Image size 2212x1659, 45-degree field of view
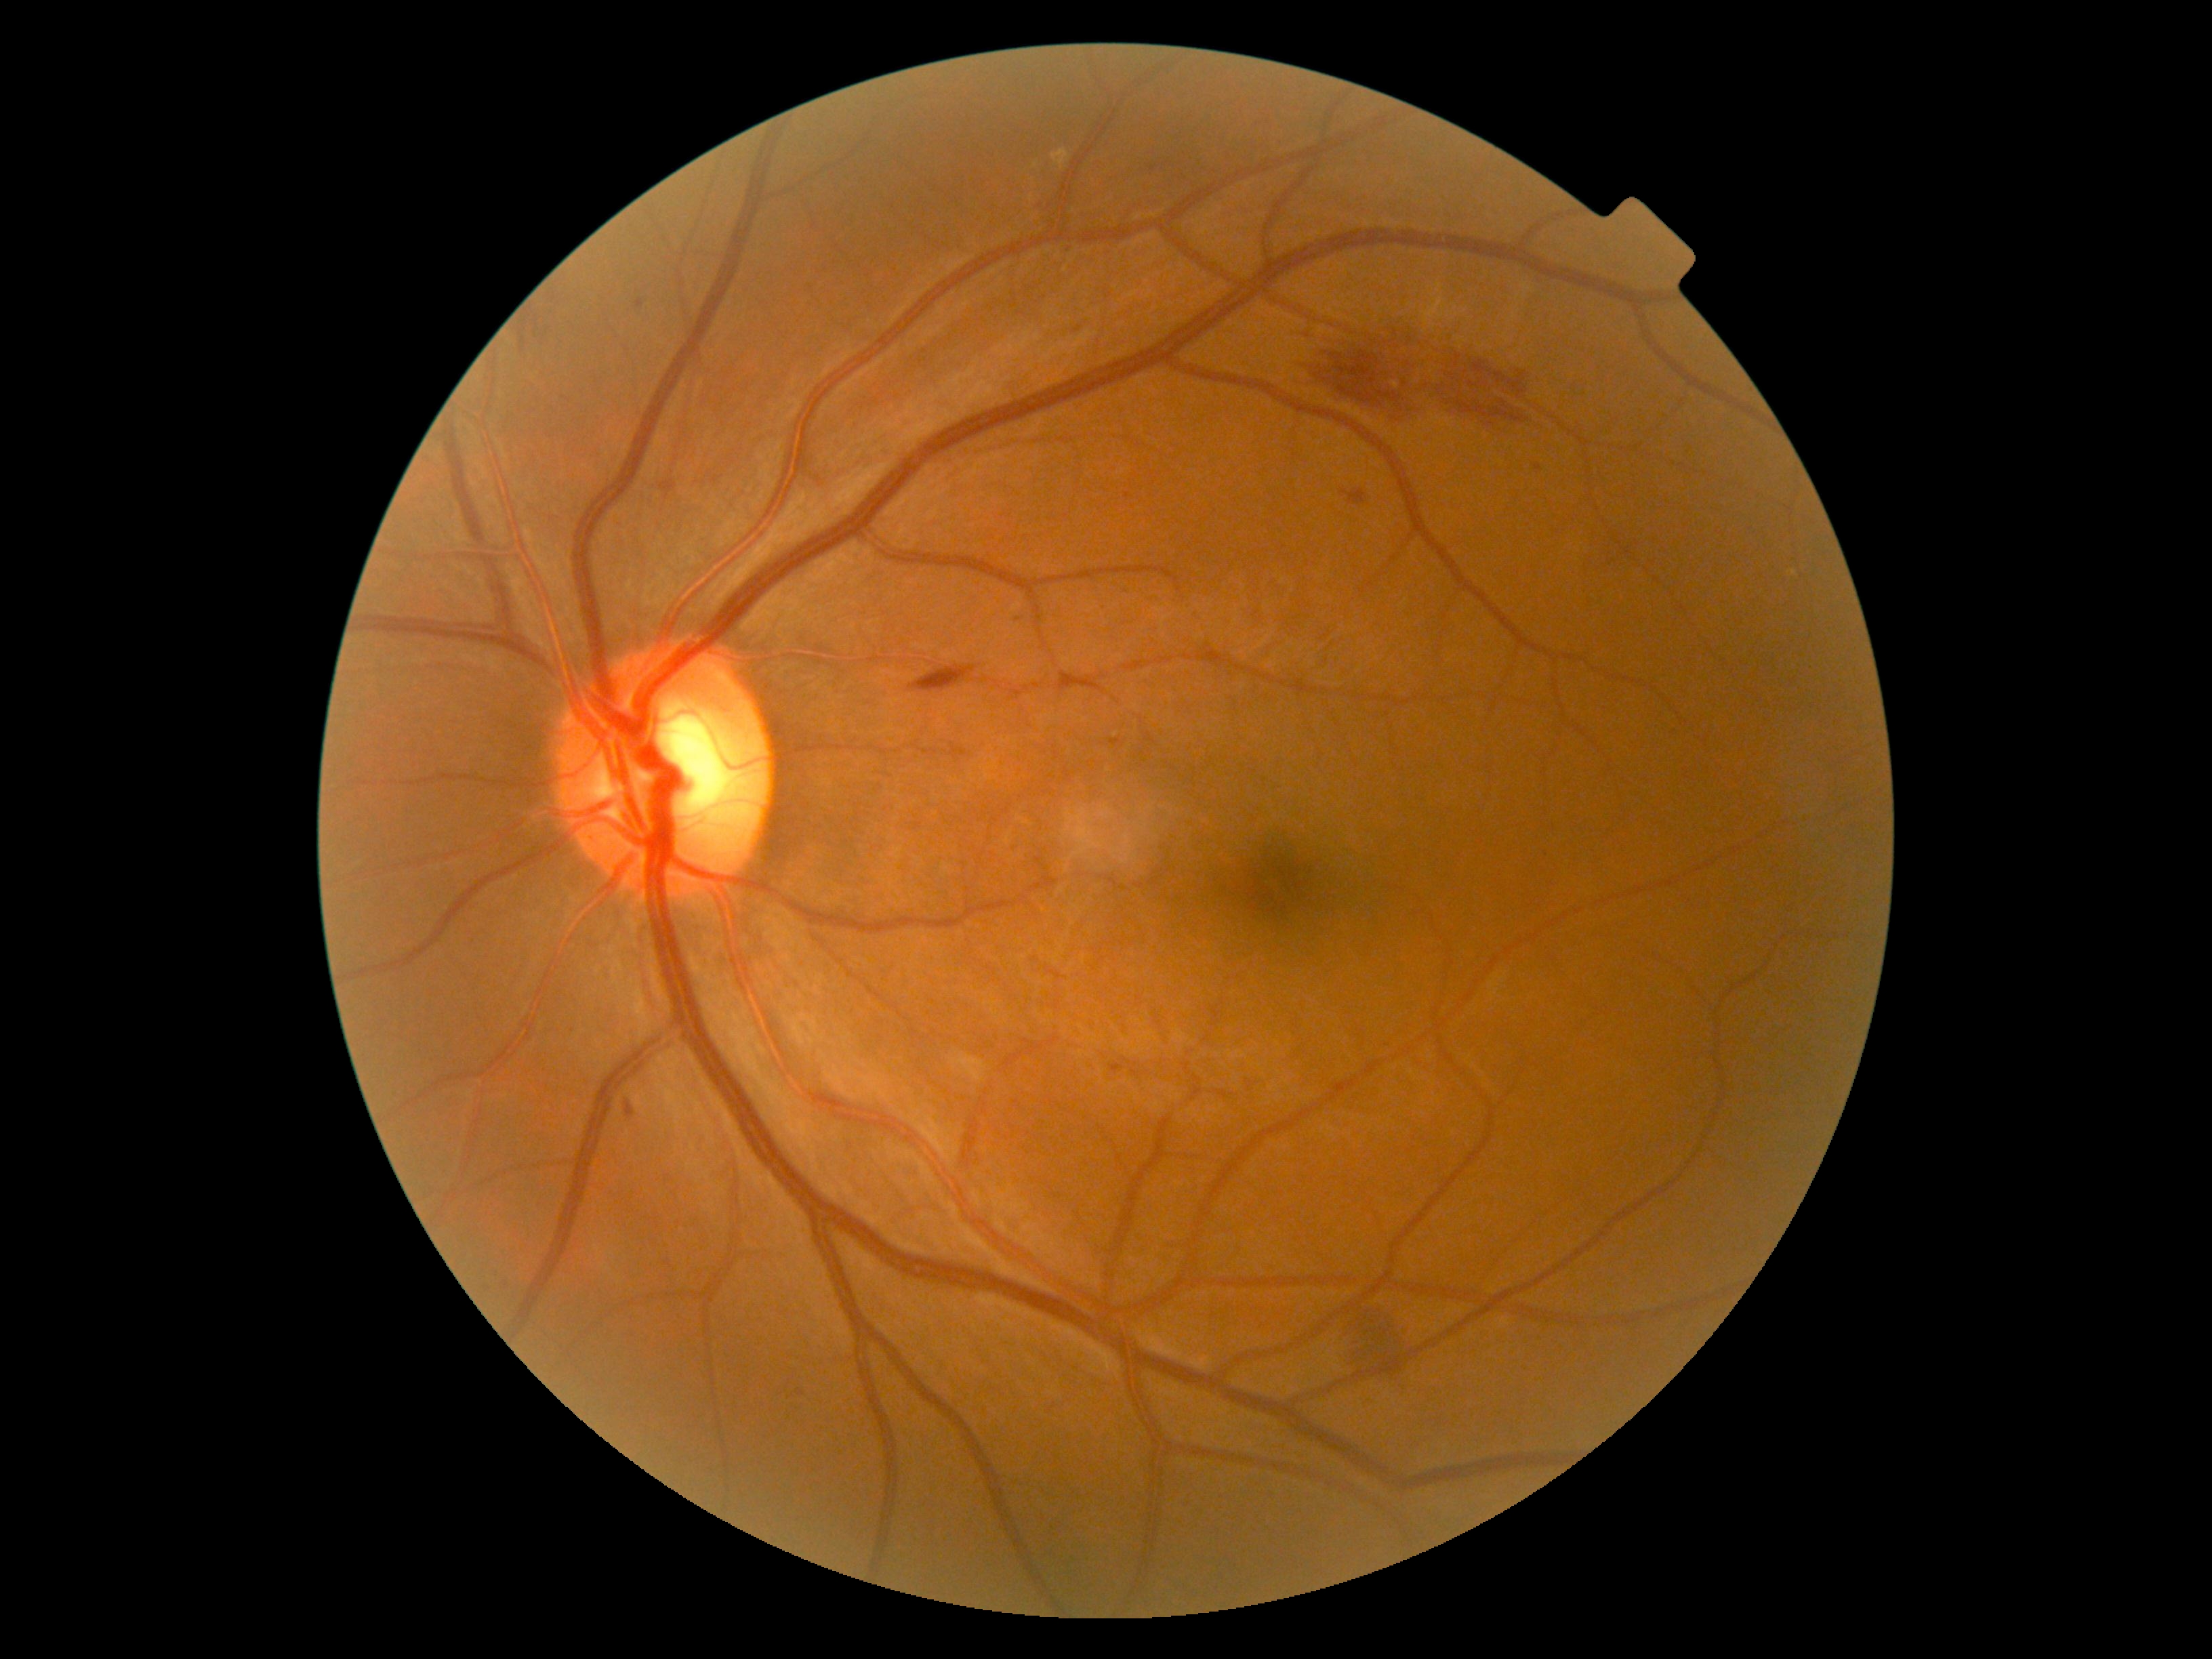

Diabetic retinopathy severity is moderate NPDR (grade 2).